Posterior pole view · retinal fundus photograph
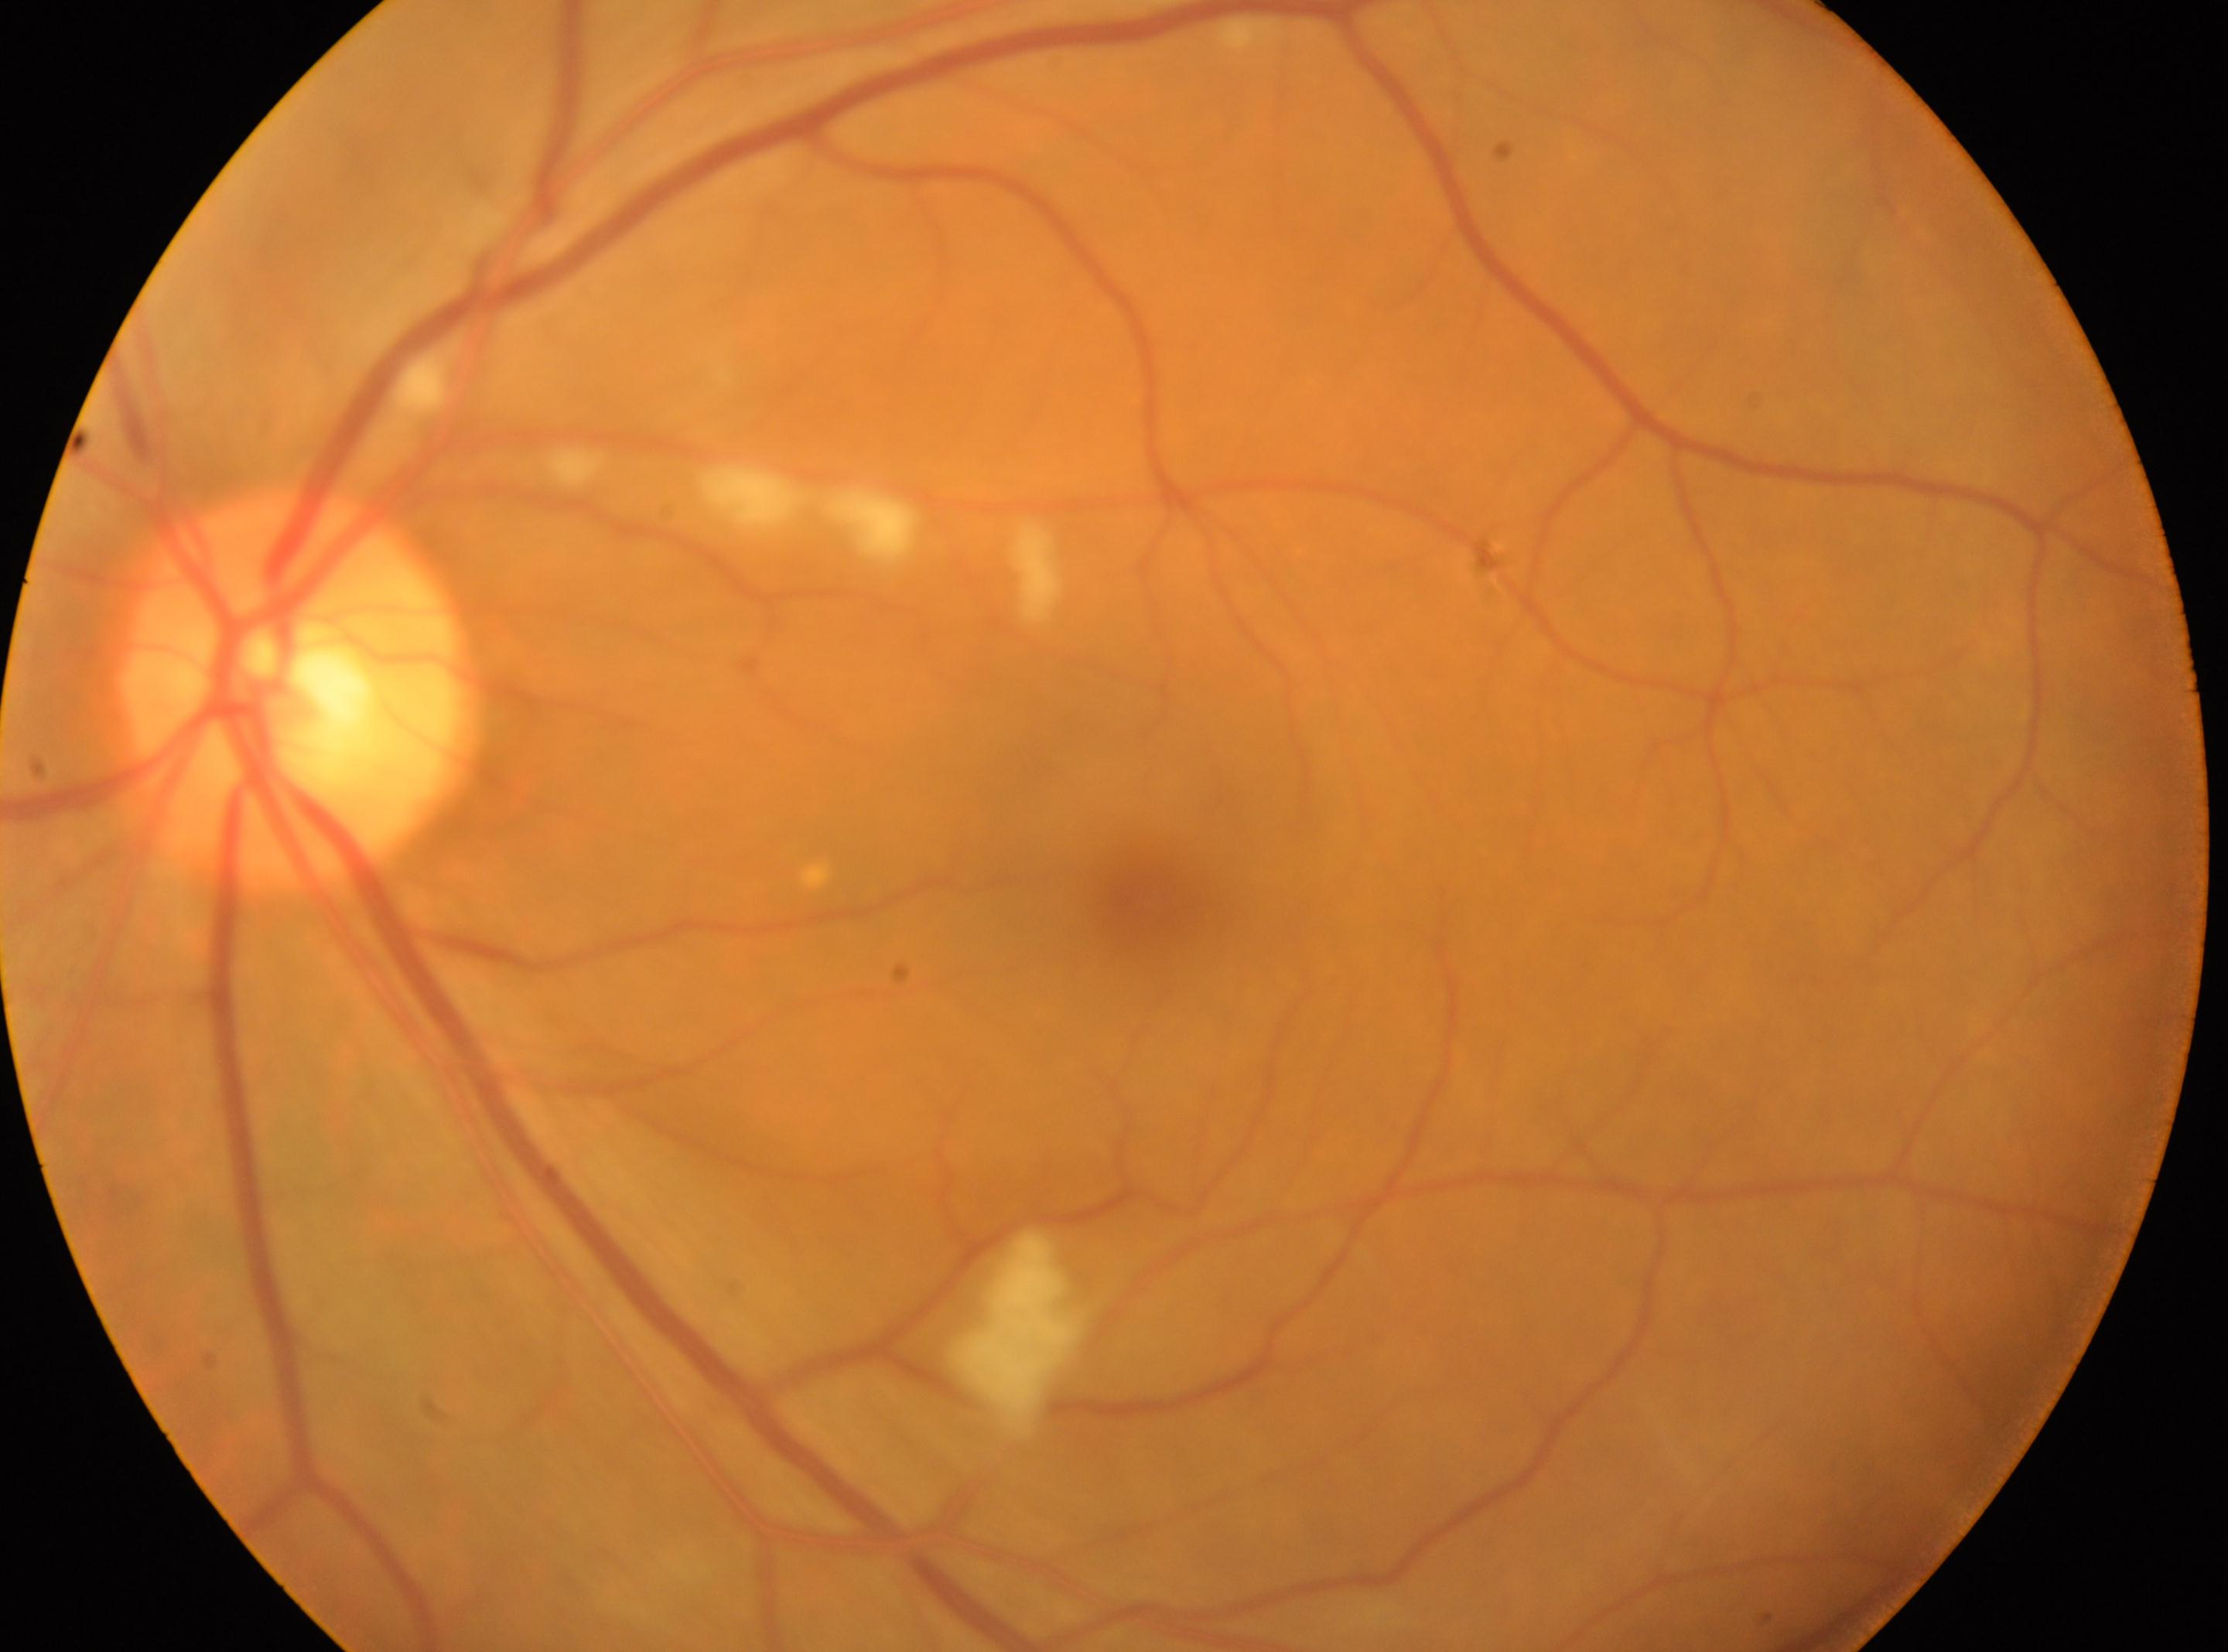
Fovea centralis: (x: 1146, y: 913). The optic disc is at (x: 289, y: 682). Imaged eye: left eye. Diabetic retinopathy severity is 2.